Retinal fundus photograph. Image size 512x512.
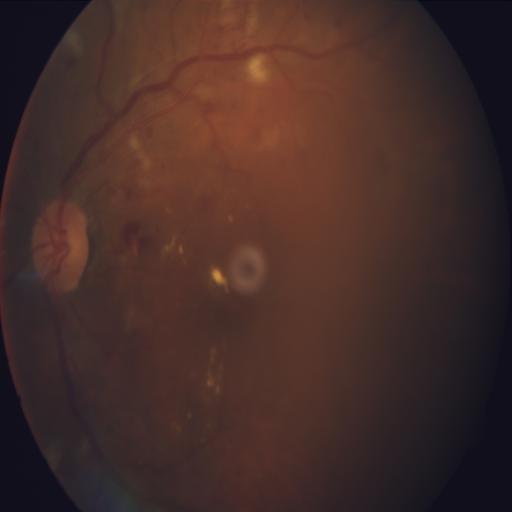 There is evidence of exudation and hemorrhagic retinopathy.